45° FOV. Image size 2352x1568 — 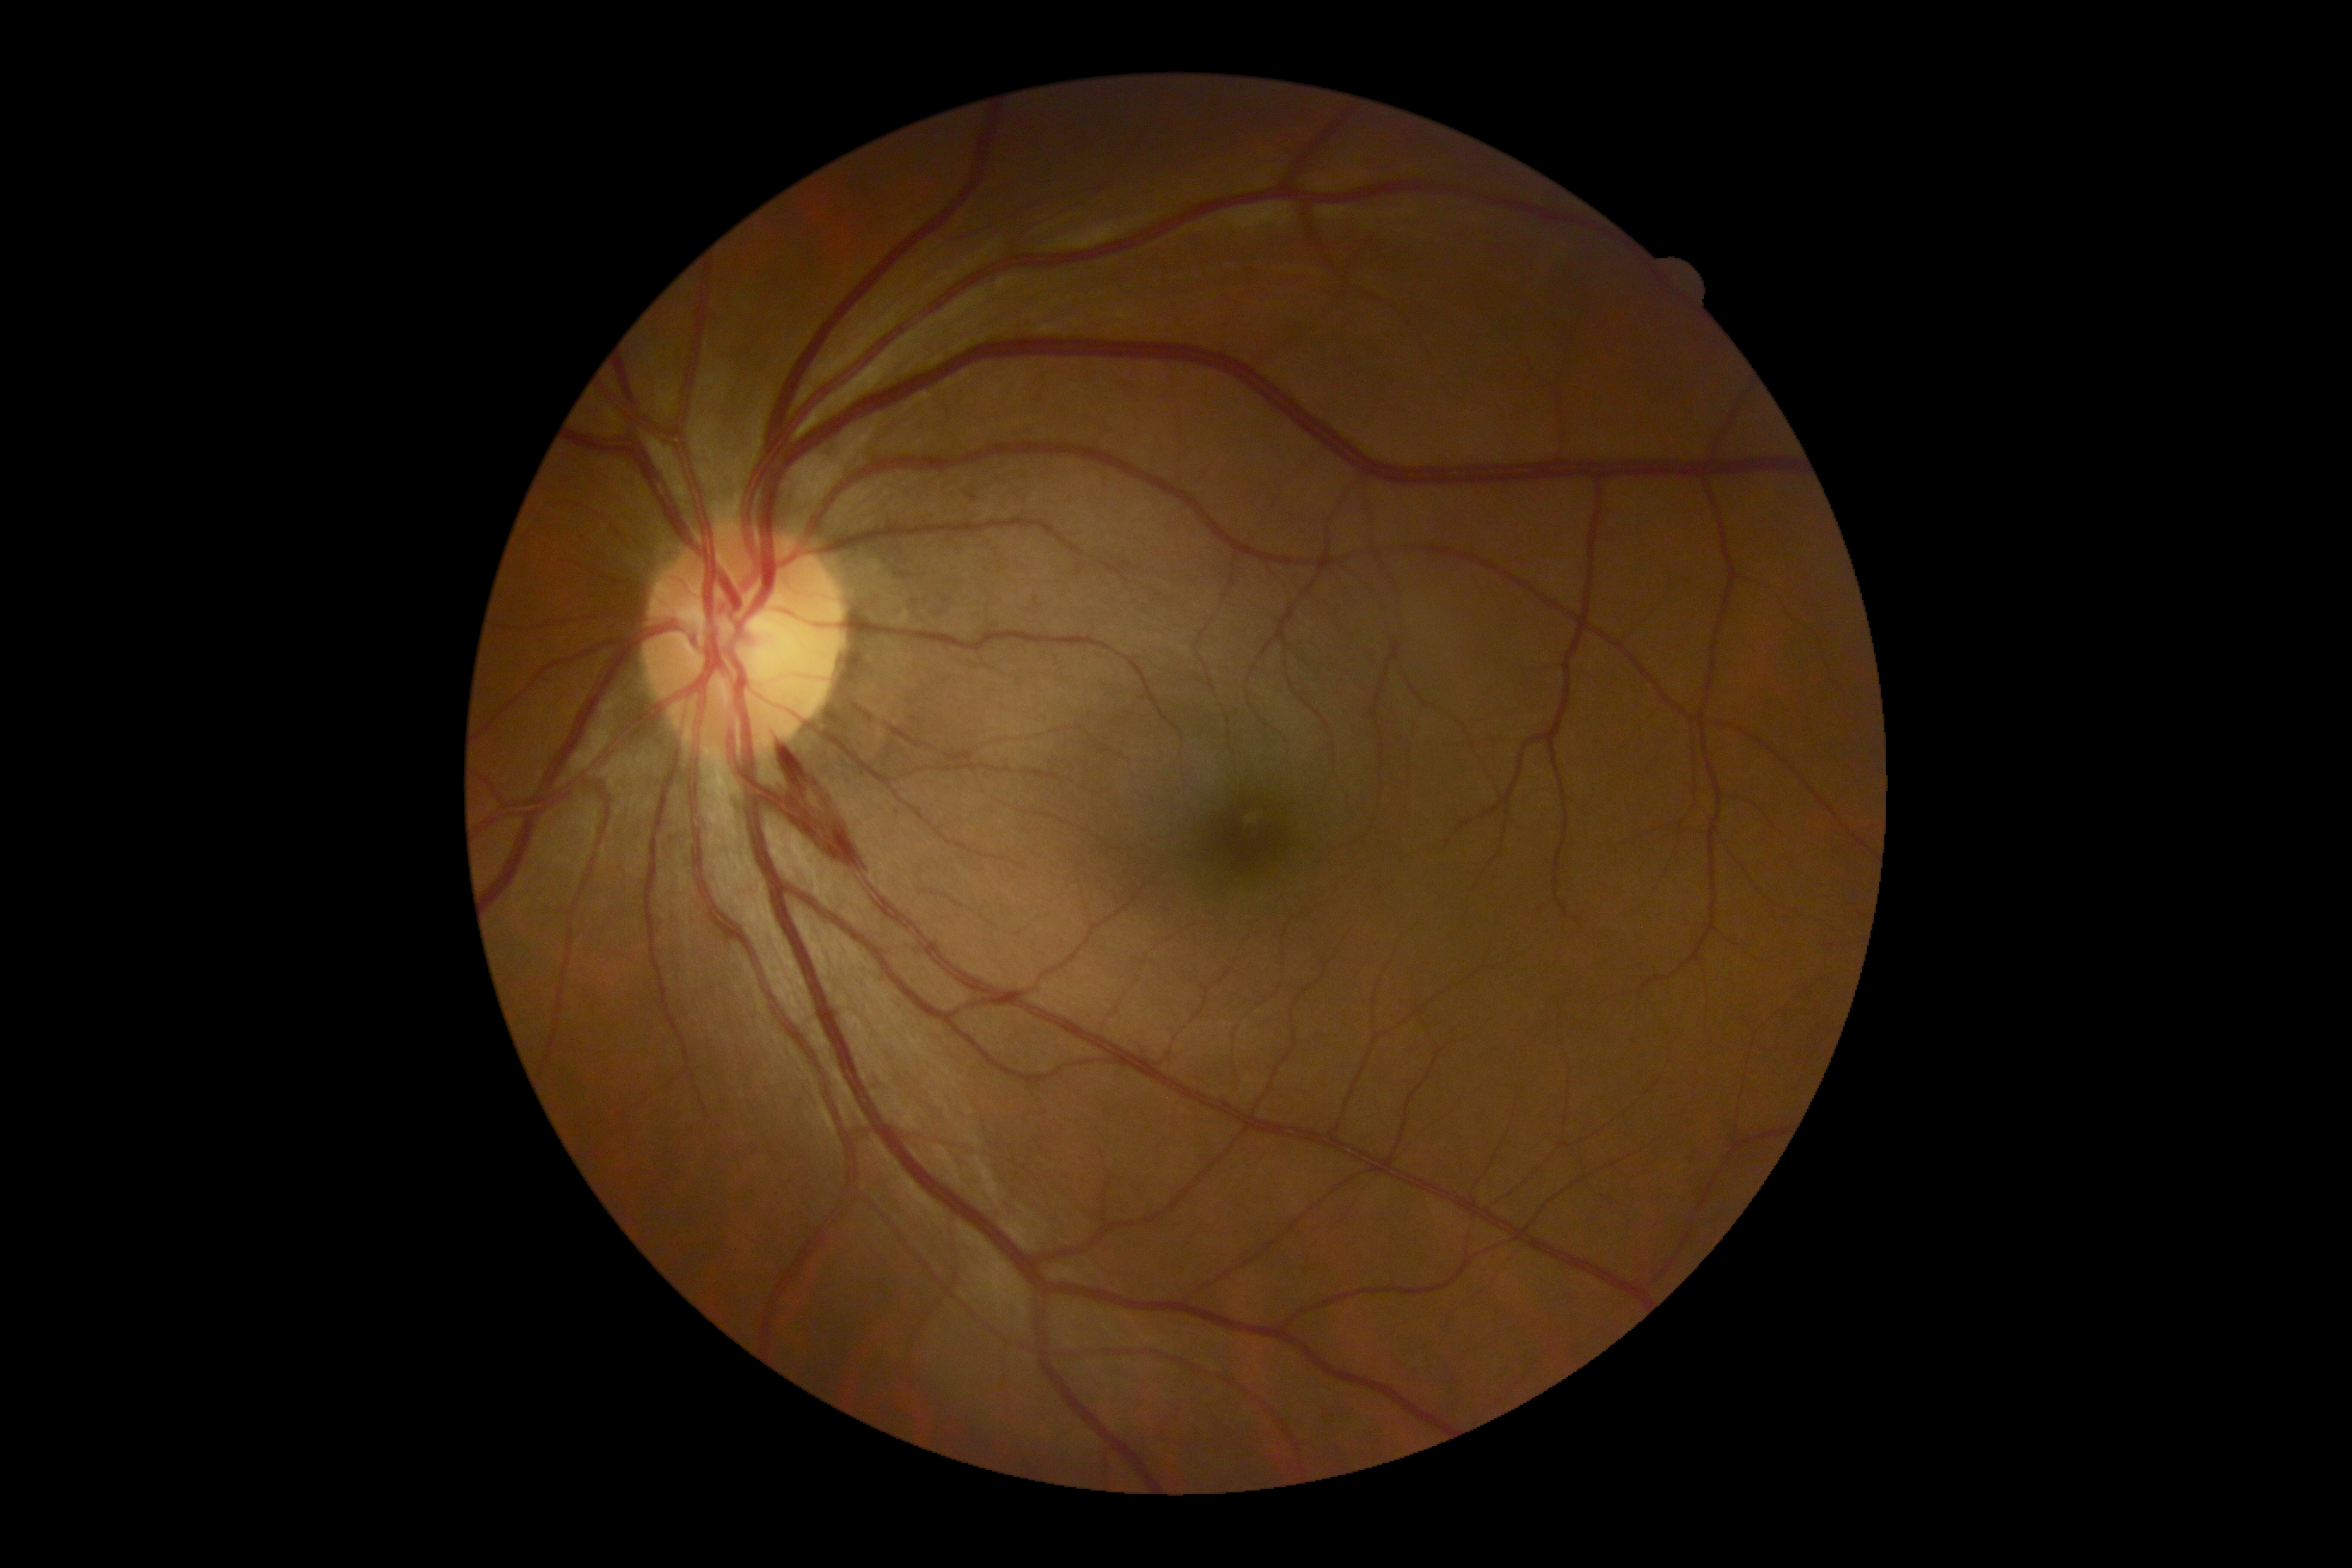

  dr_grade: moderate NPDR (grade 2) — more than just microaneurysms but less than severe NPDR